45-degree field of view · color fundus image · 2212 by 1659 pixels: 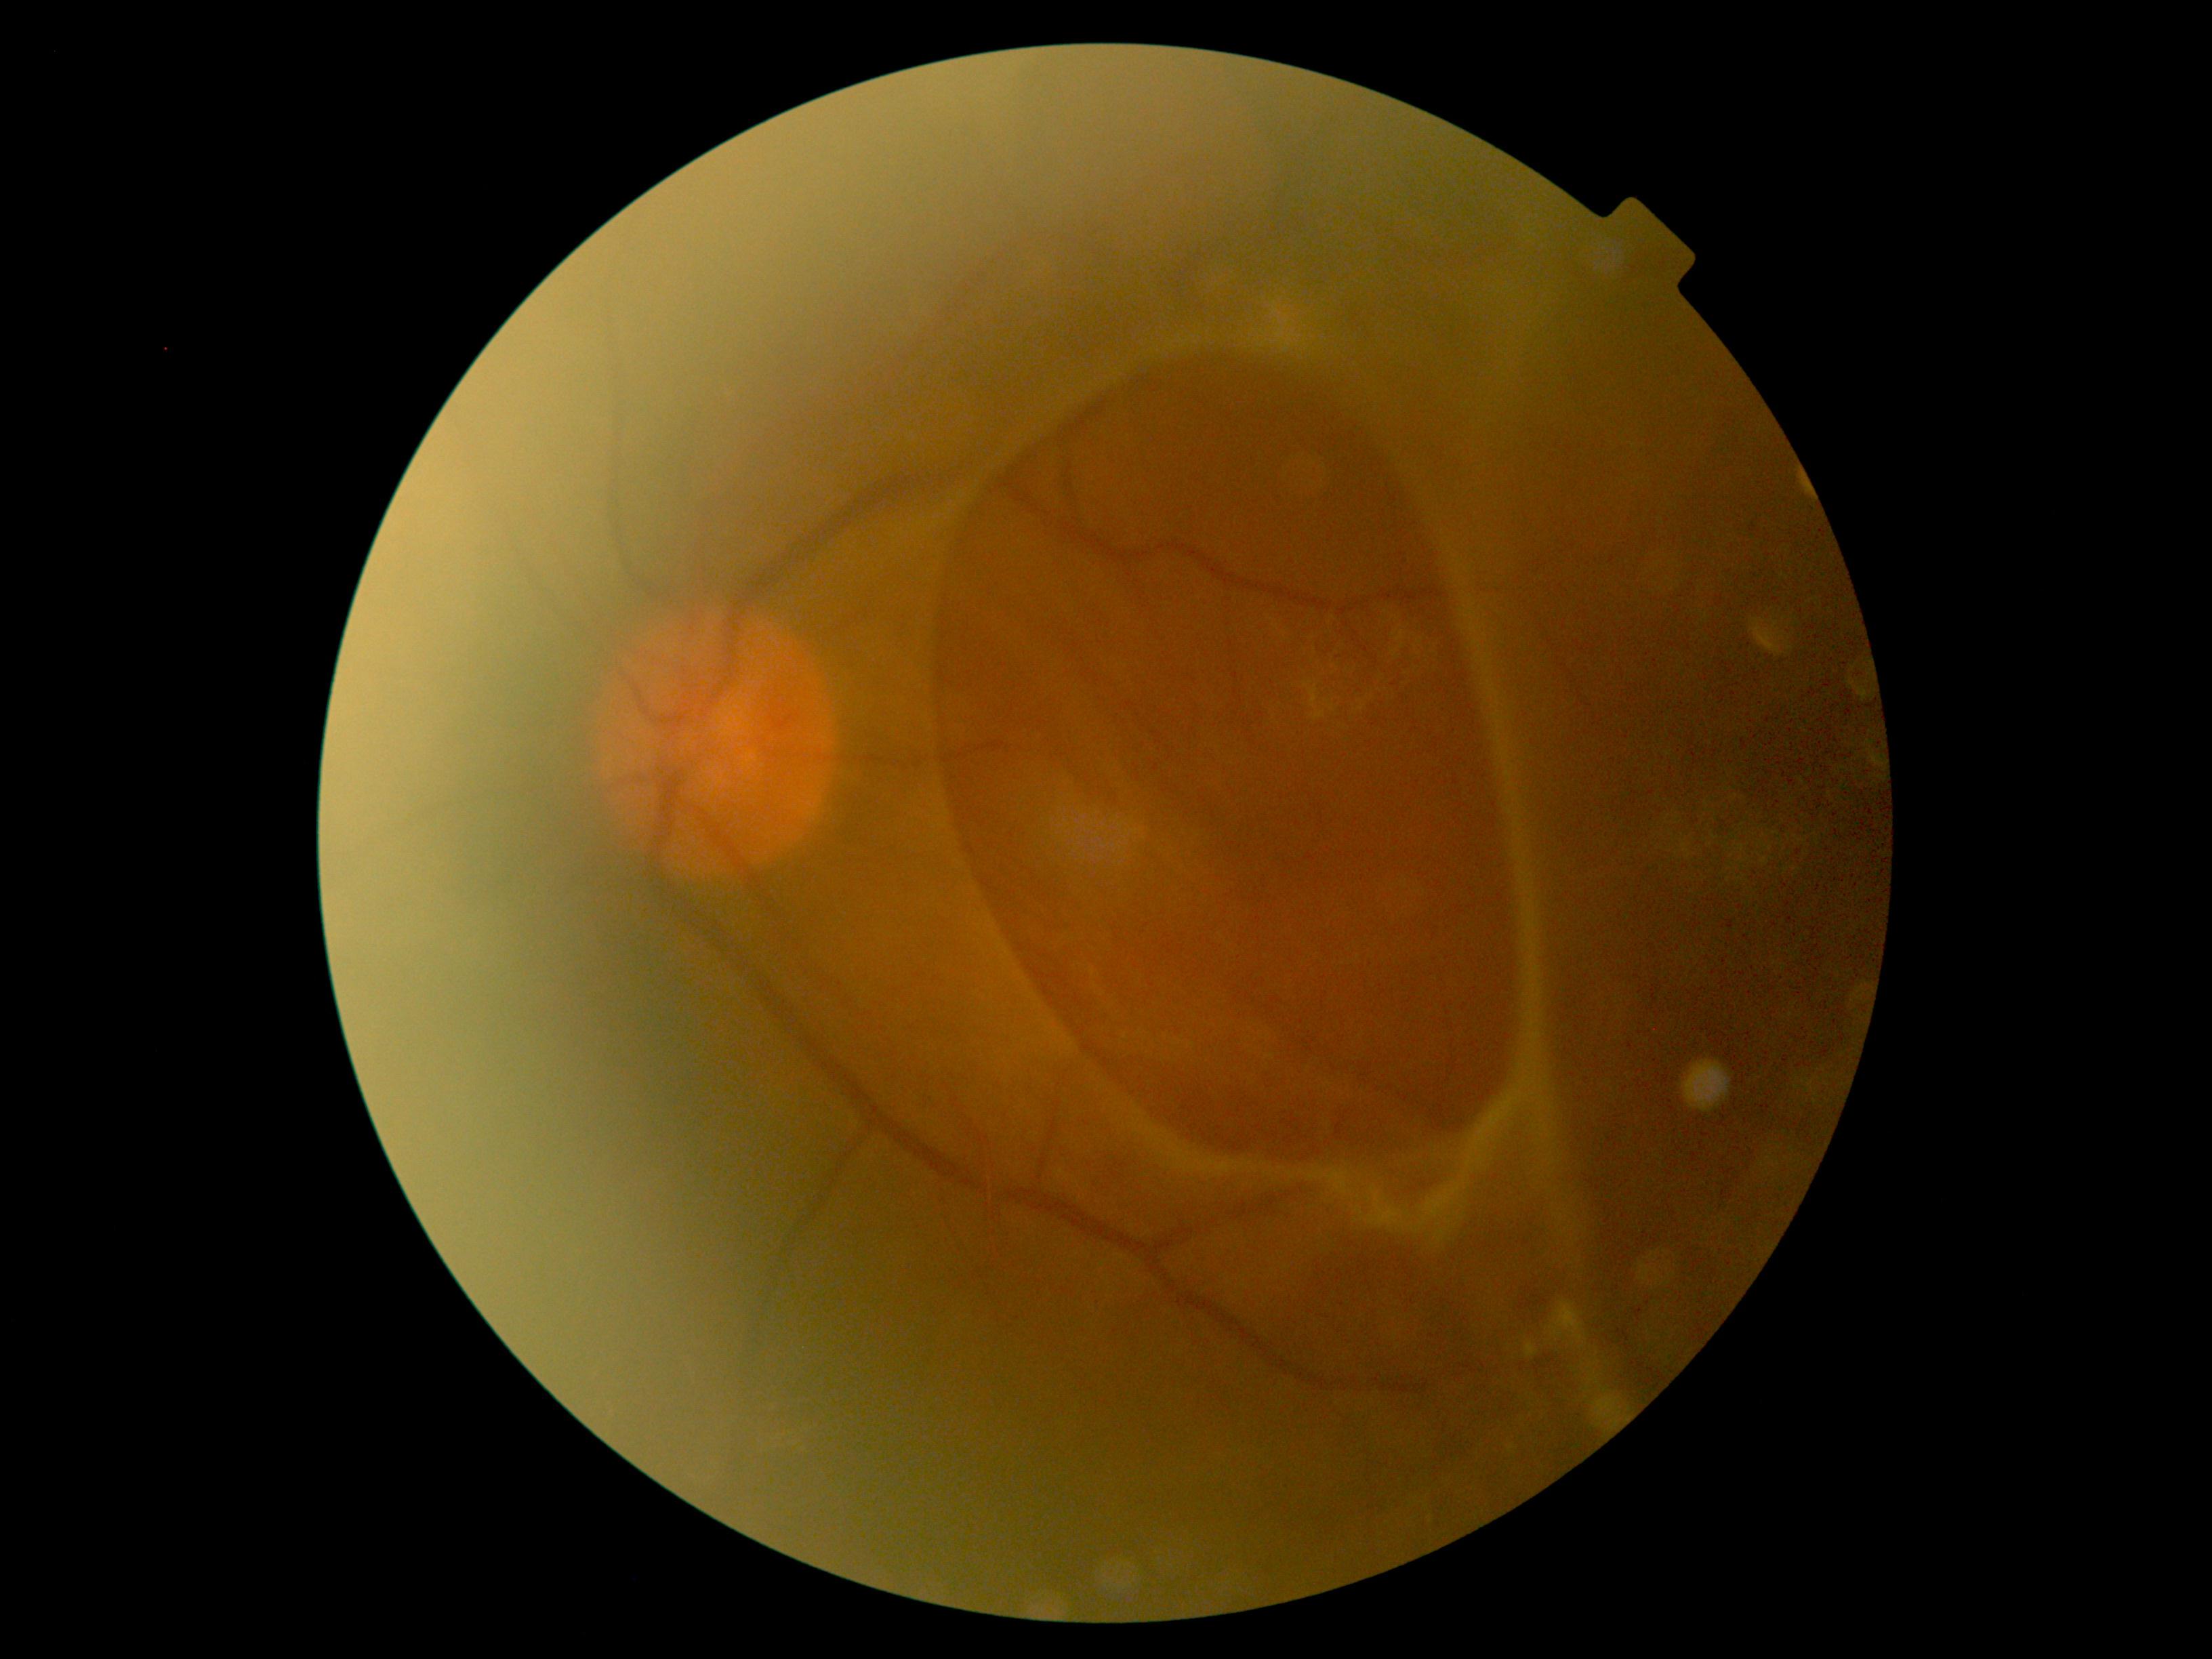

DR class = proliferative diabetic retinopathy; diabetic retinopathy (DR) = grade 4 (PDR) — neovascularization and/or vitreous/pre-retinal hemorrhage.